Remidio Fundus on Phone (FOP) camera · CFP — 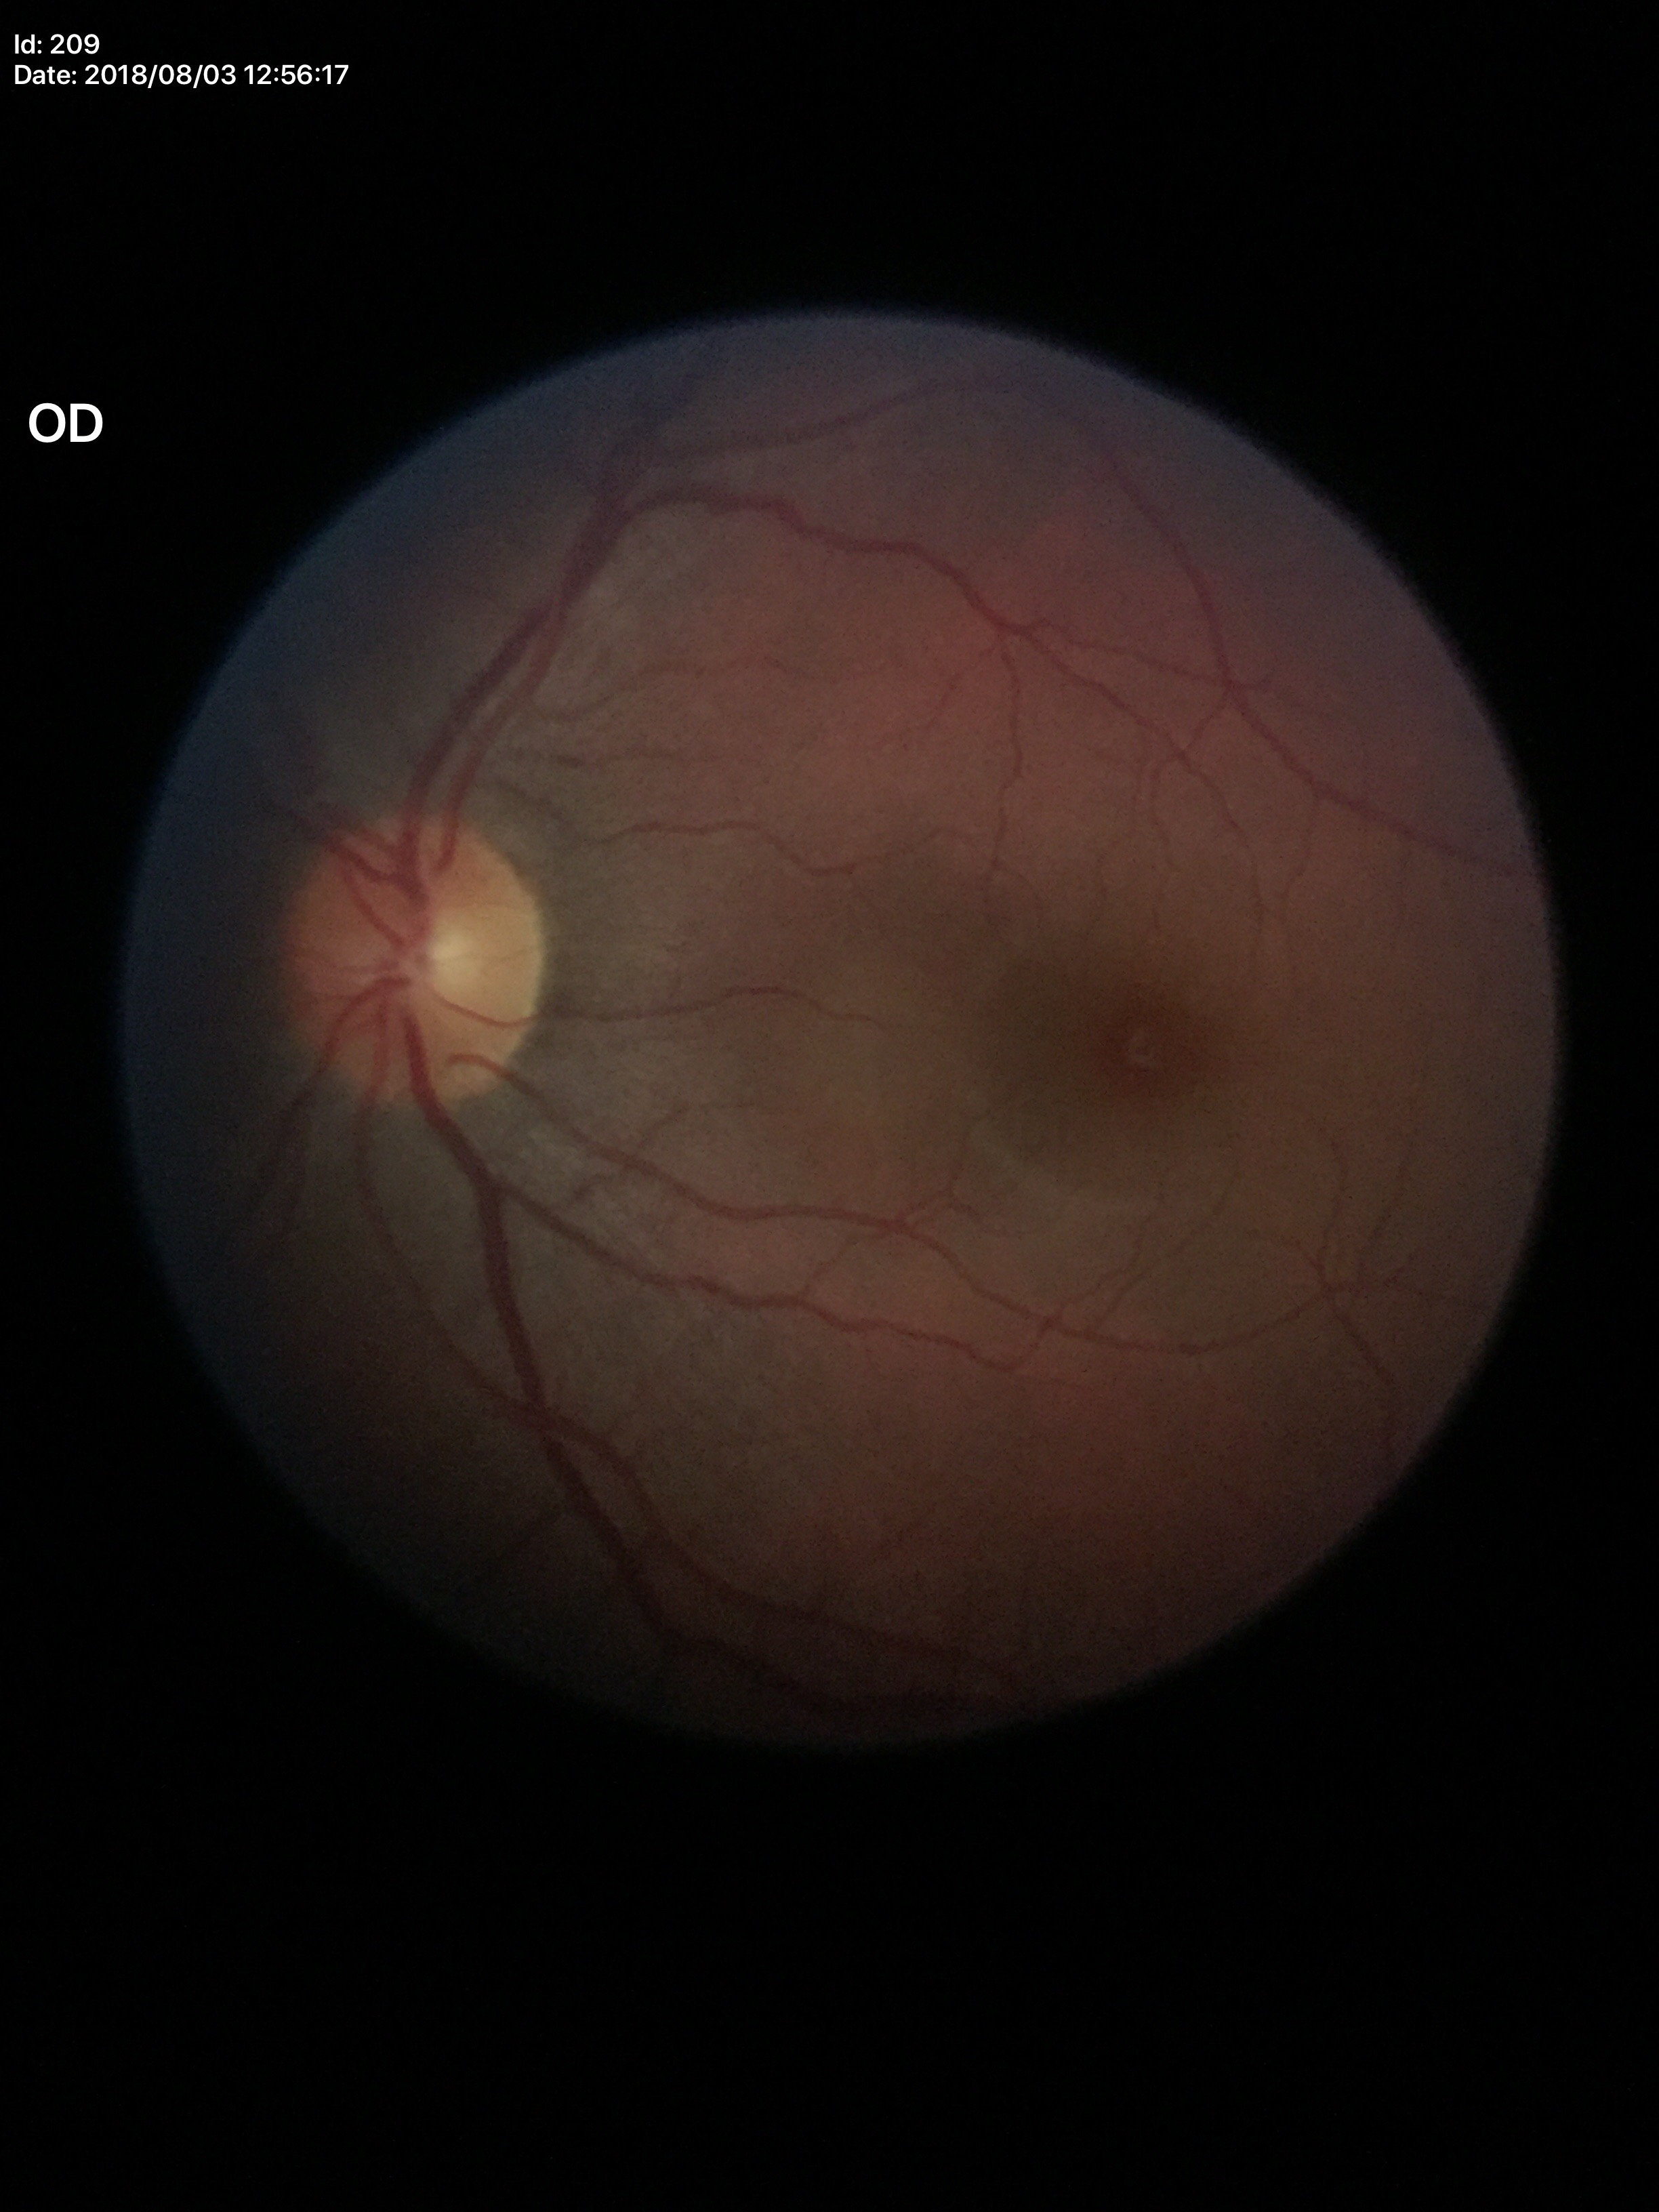
Glaucoma evaluation: negative.
Vertical CDR of 0.41.